Color fundus image — 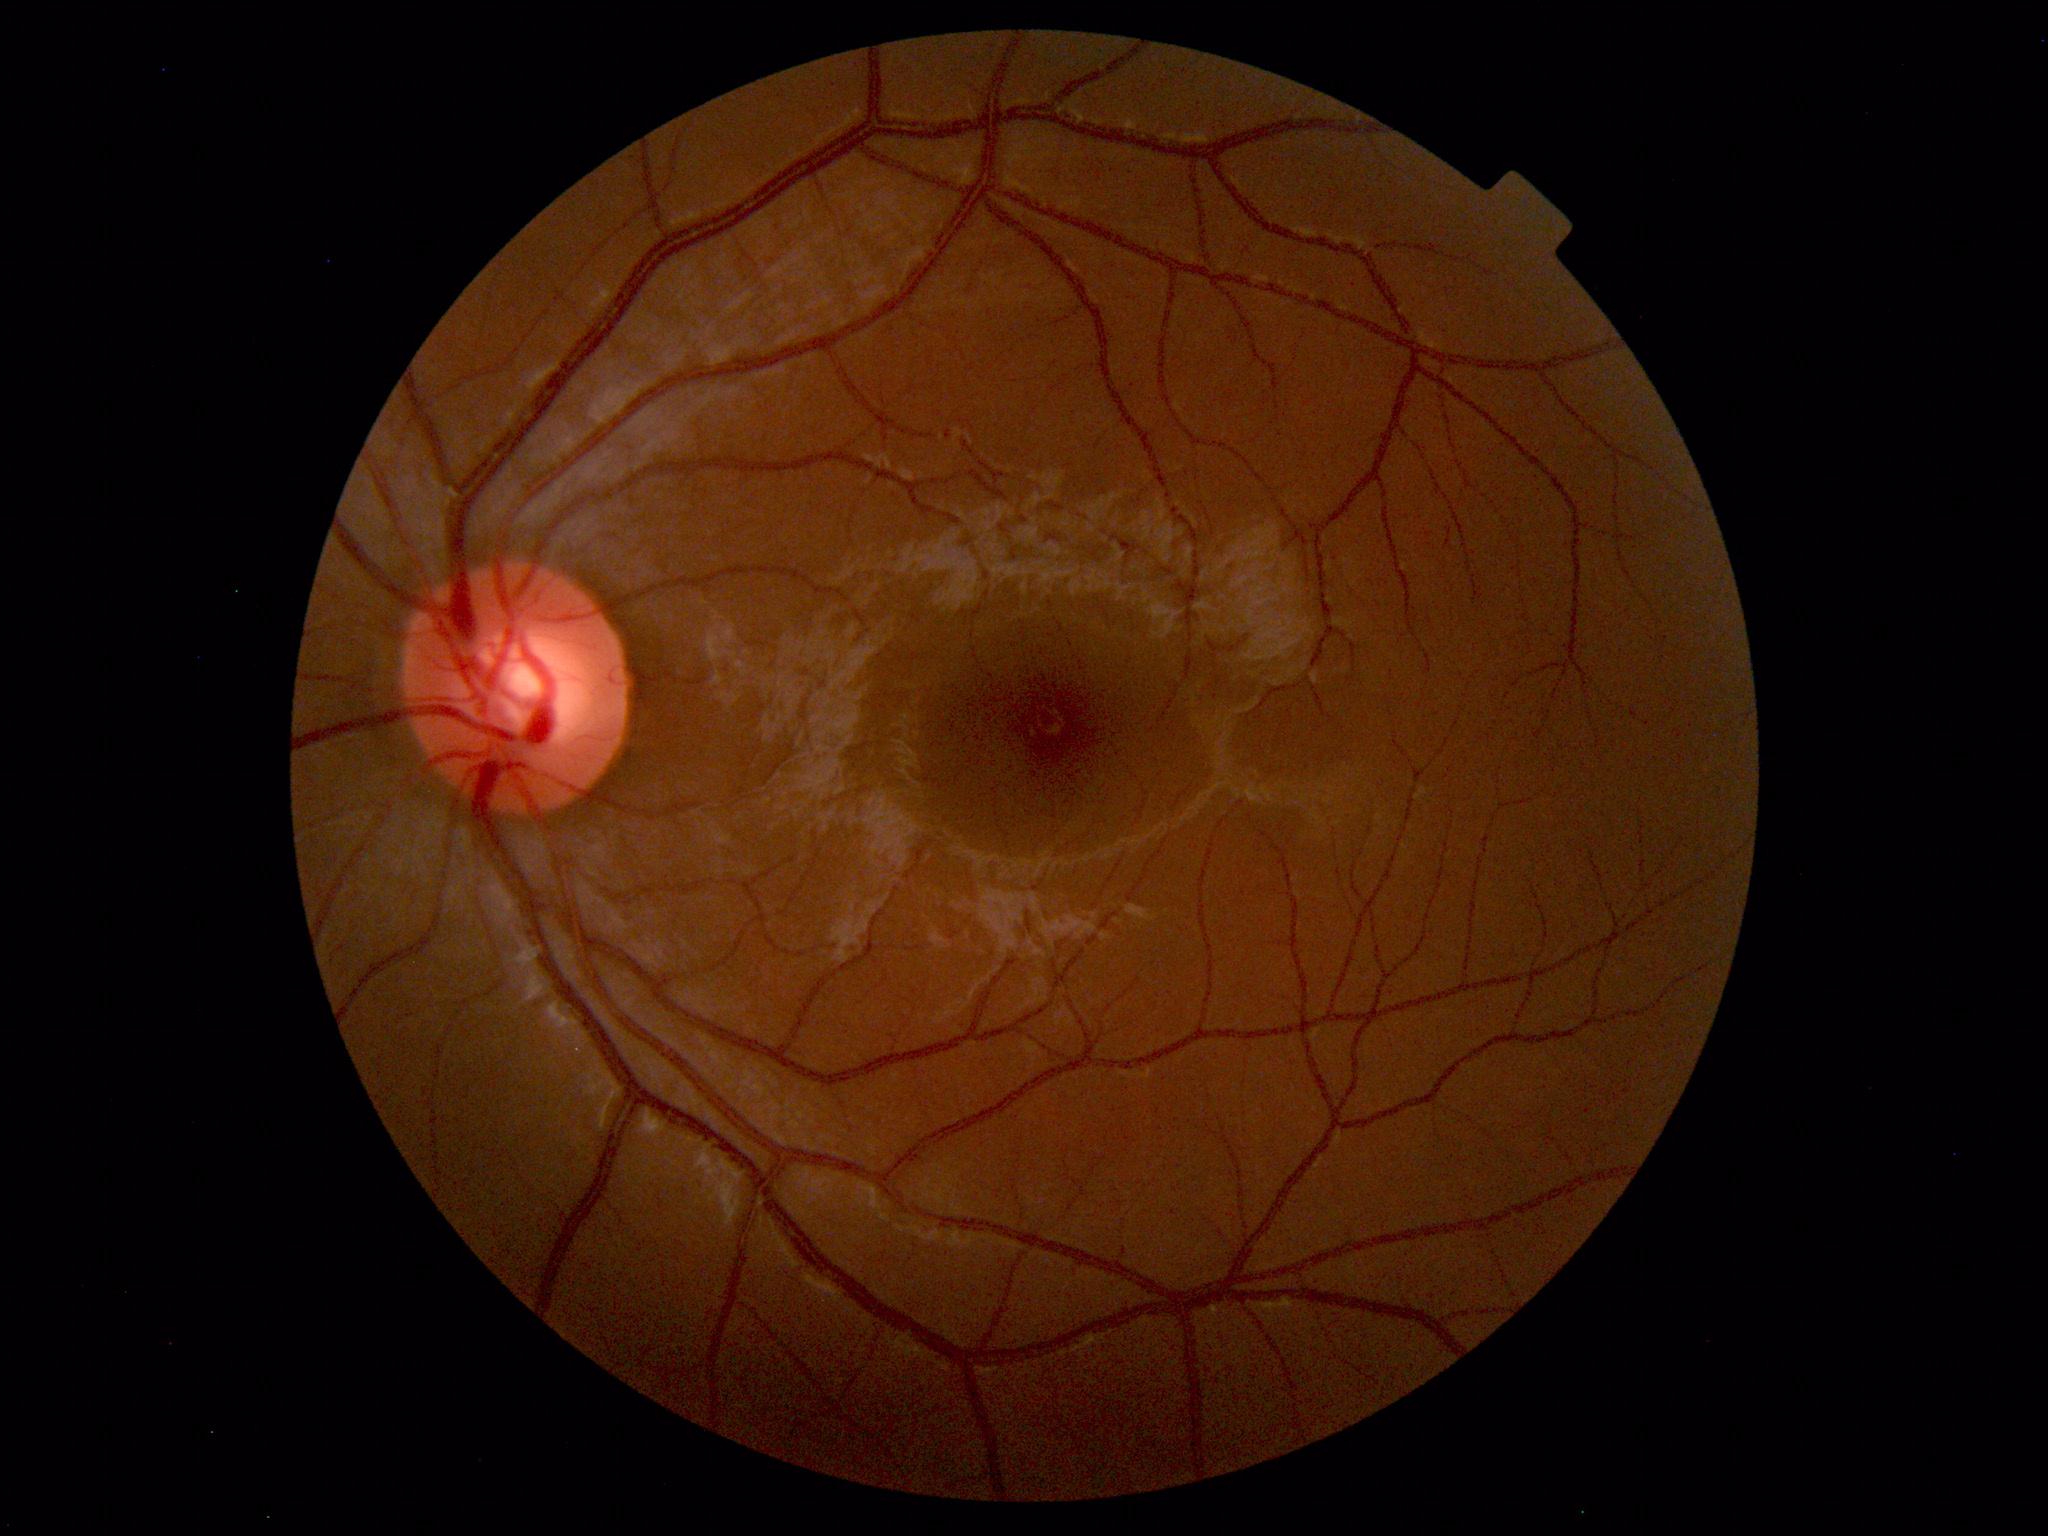

Impression: normal fundus.